2048x1536
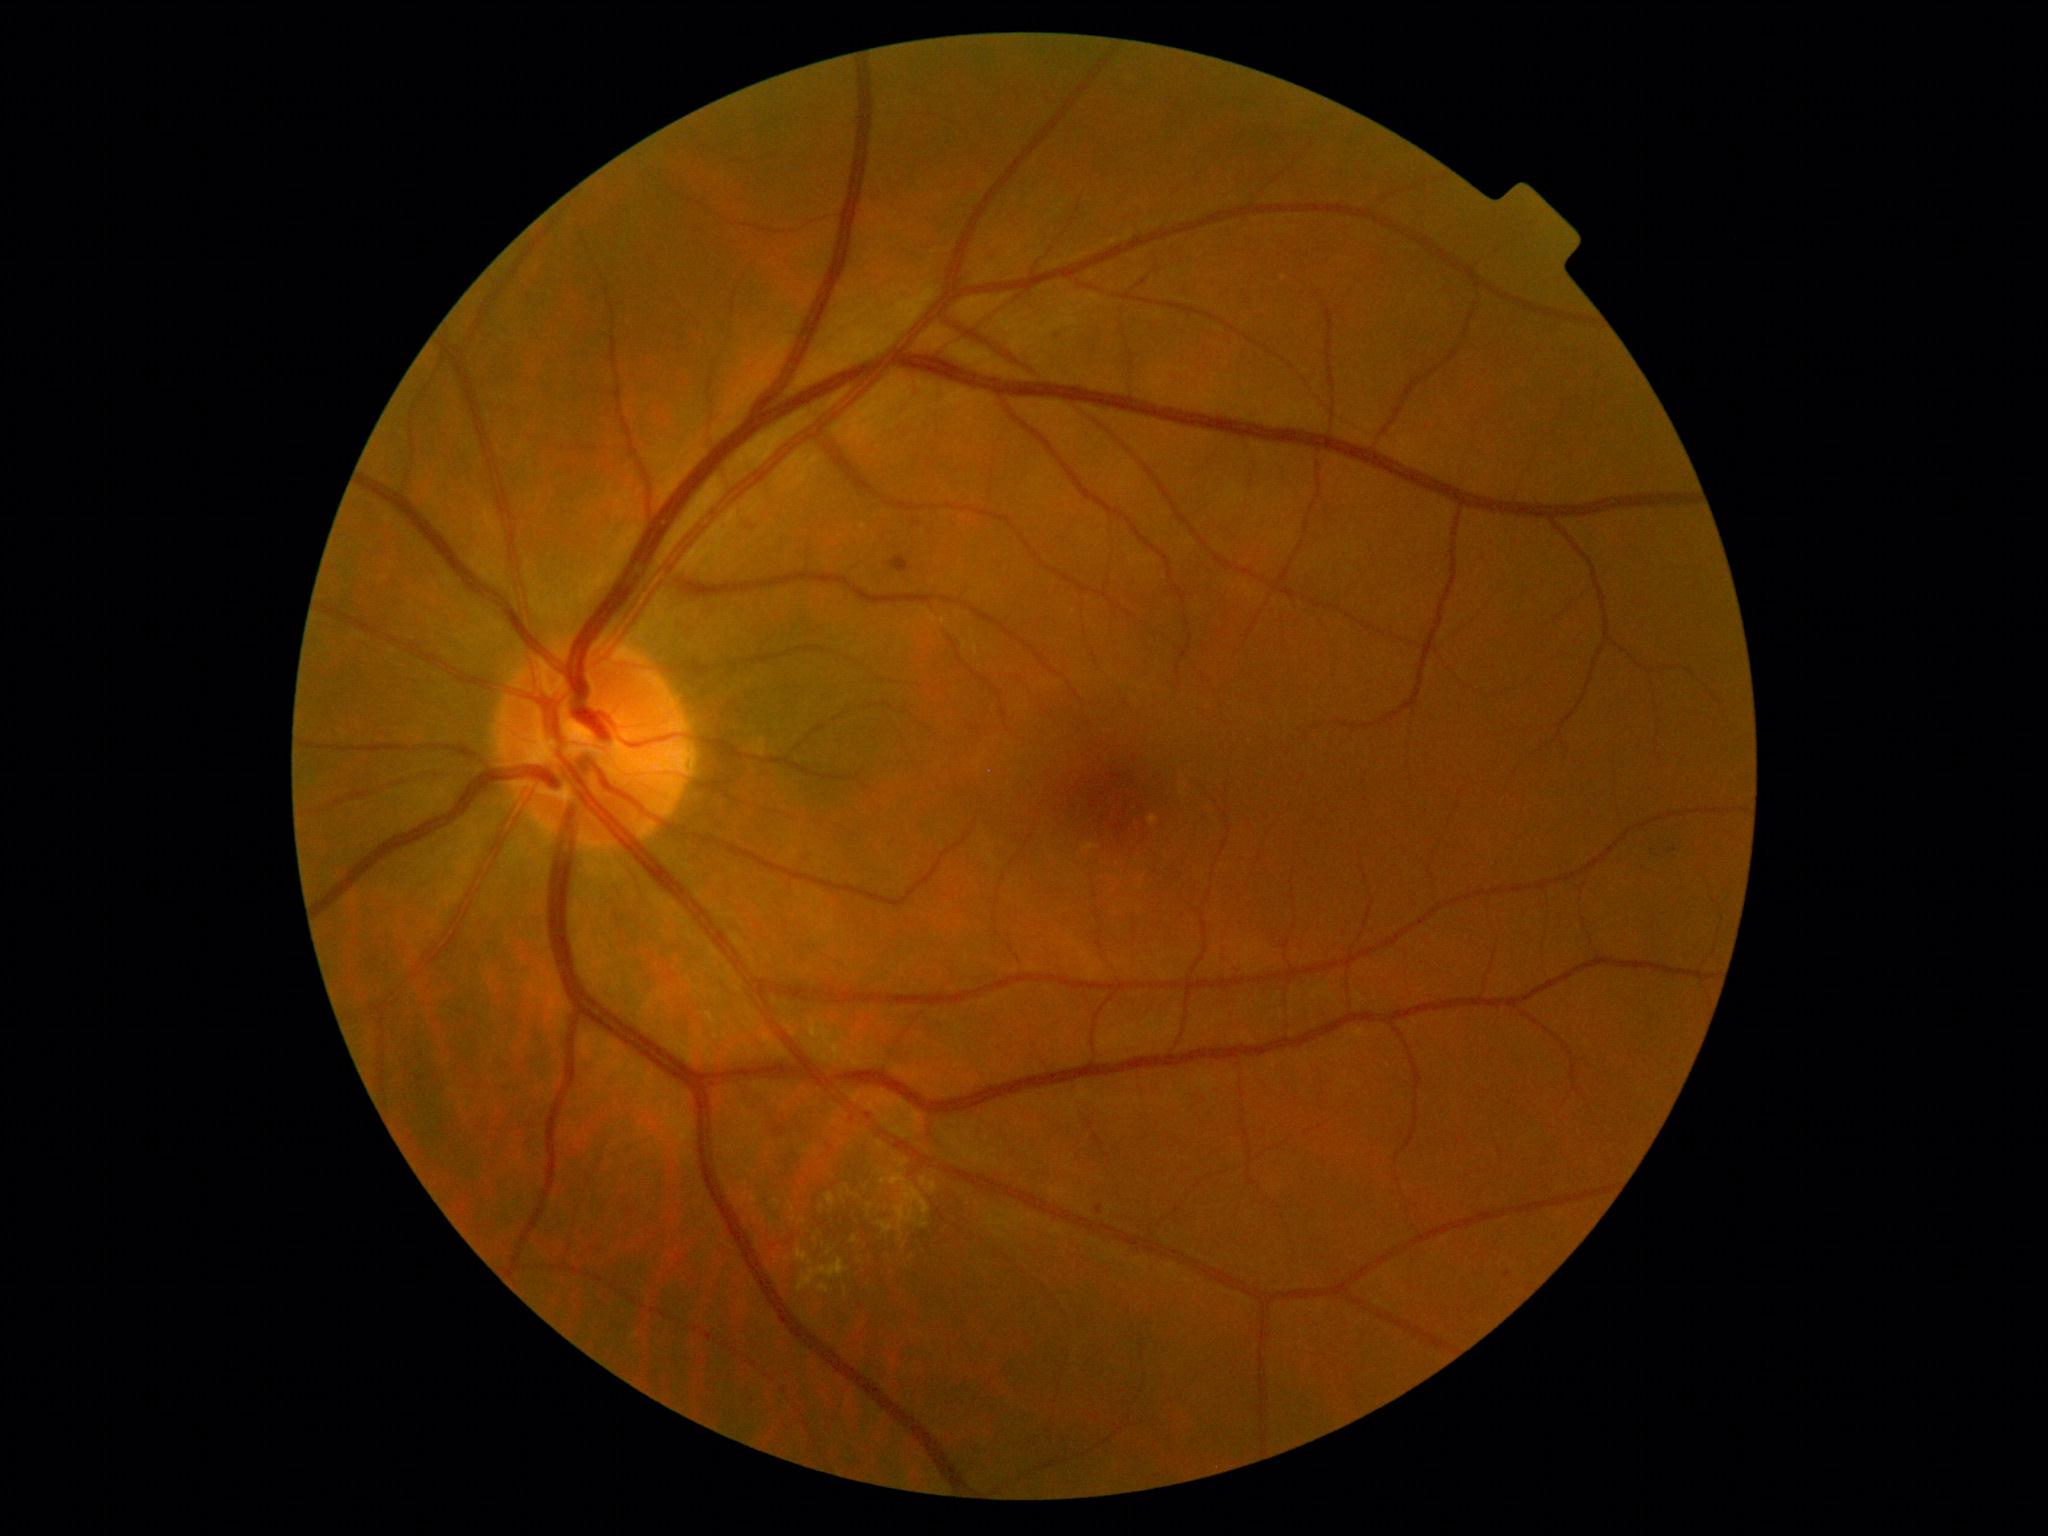

DR severity is moderate NPDR (grade 2) — more than just microaneurysms but less than severe NPDR.